FOV: 45 degrees. Fundus photo. 2212x1659.
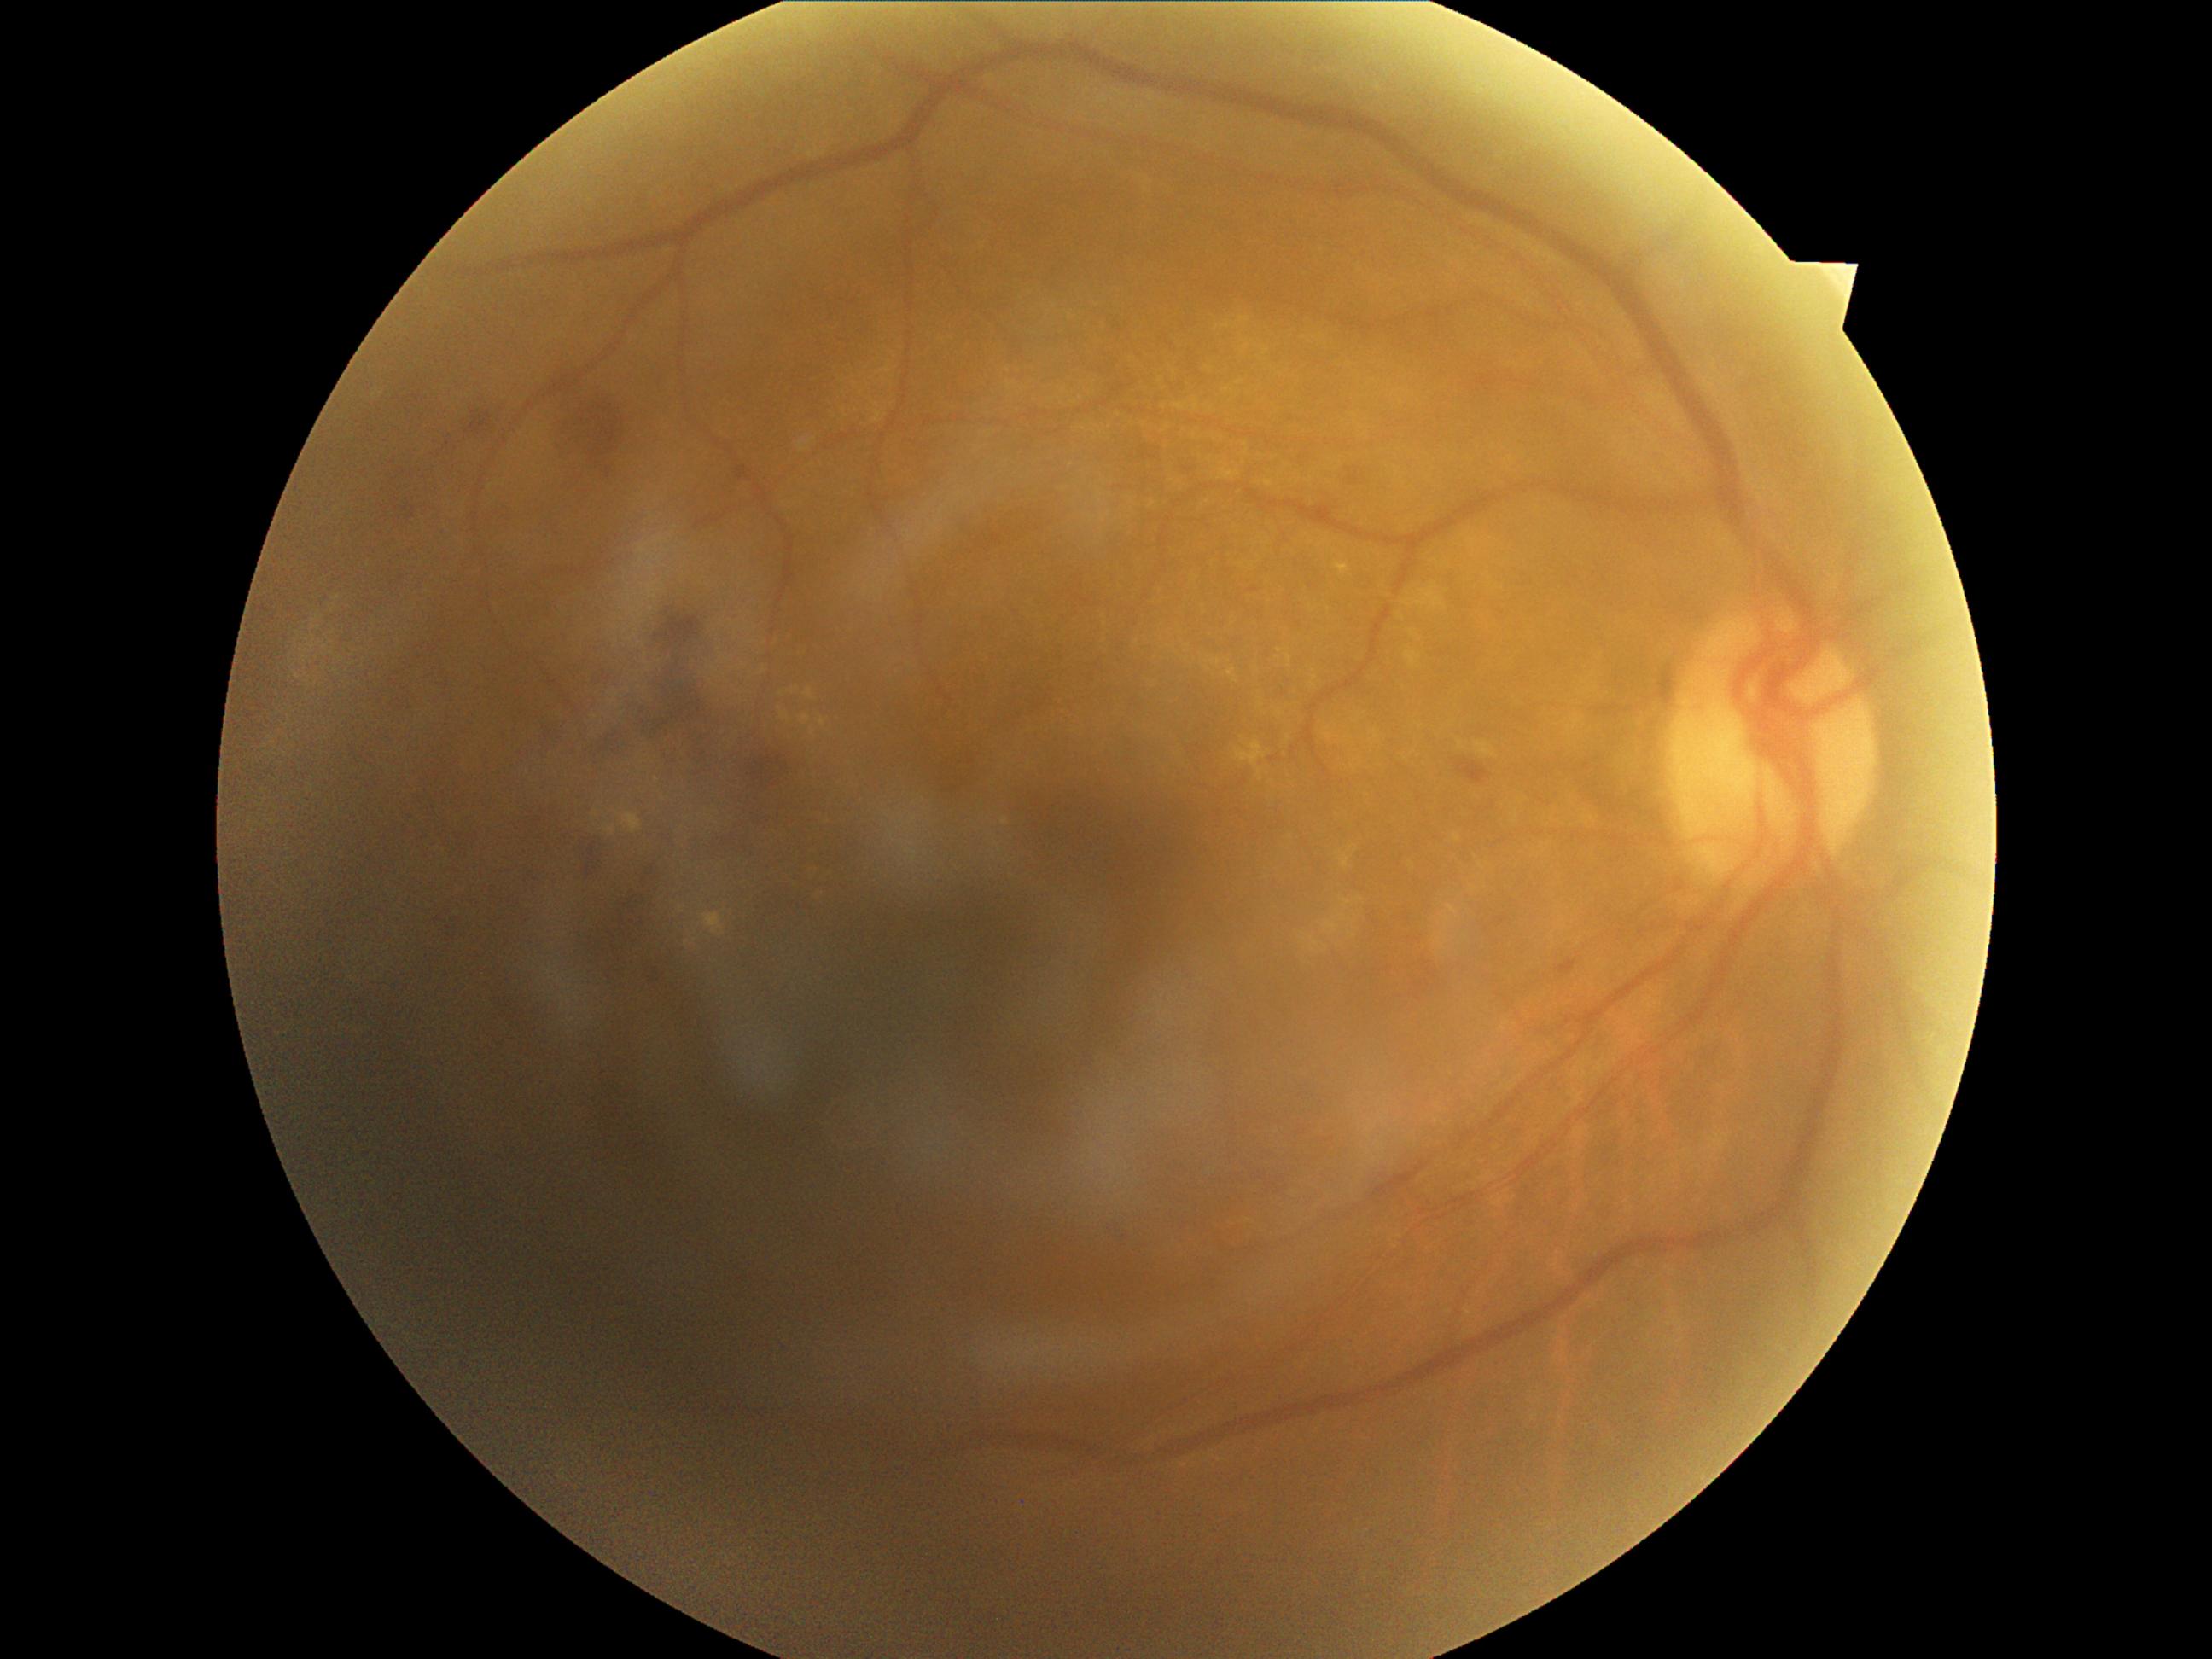 diabetic retinopathy (DR)@moderate NPDR (grade 2).